Fundus photo; 45-degree field of view
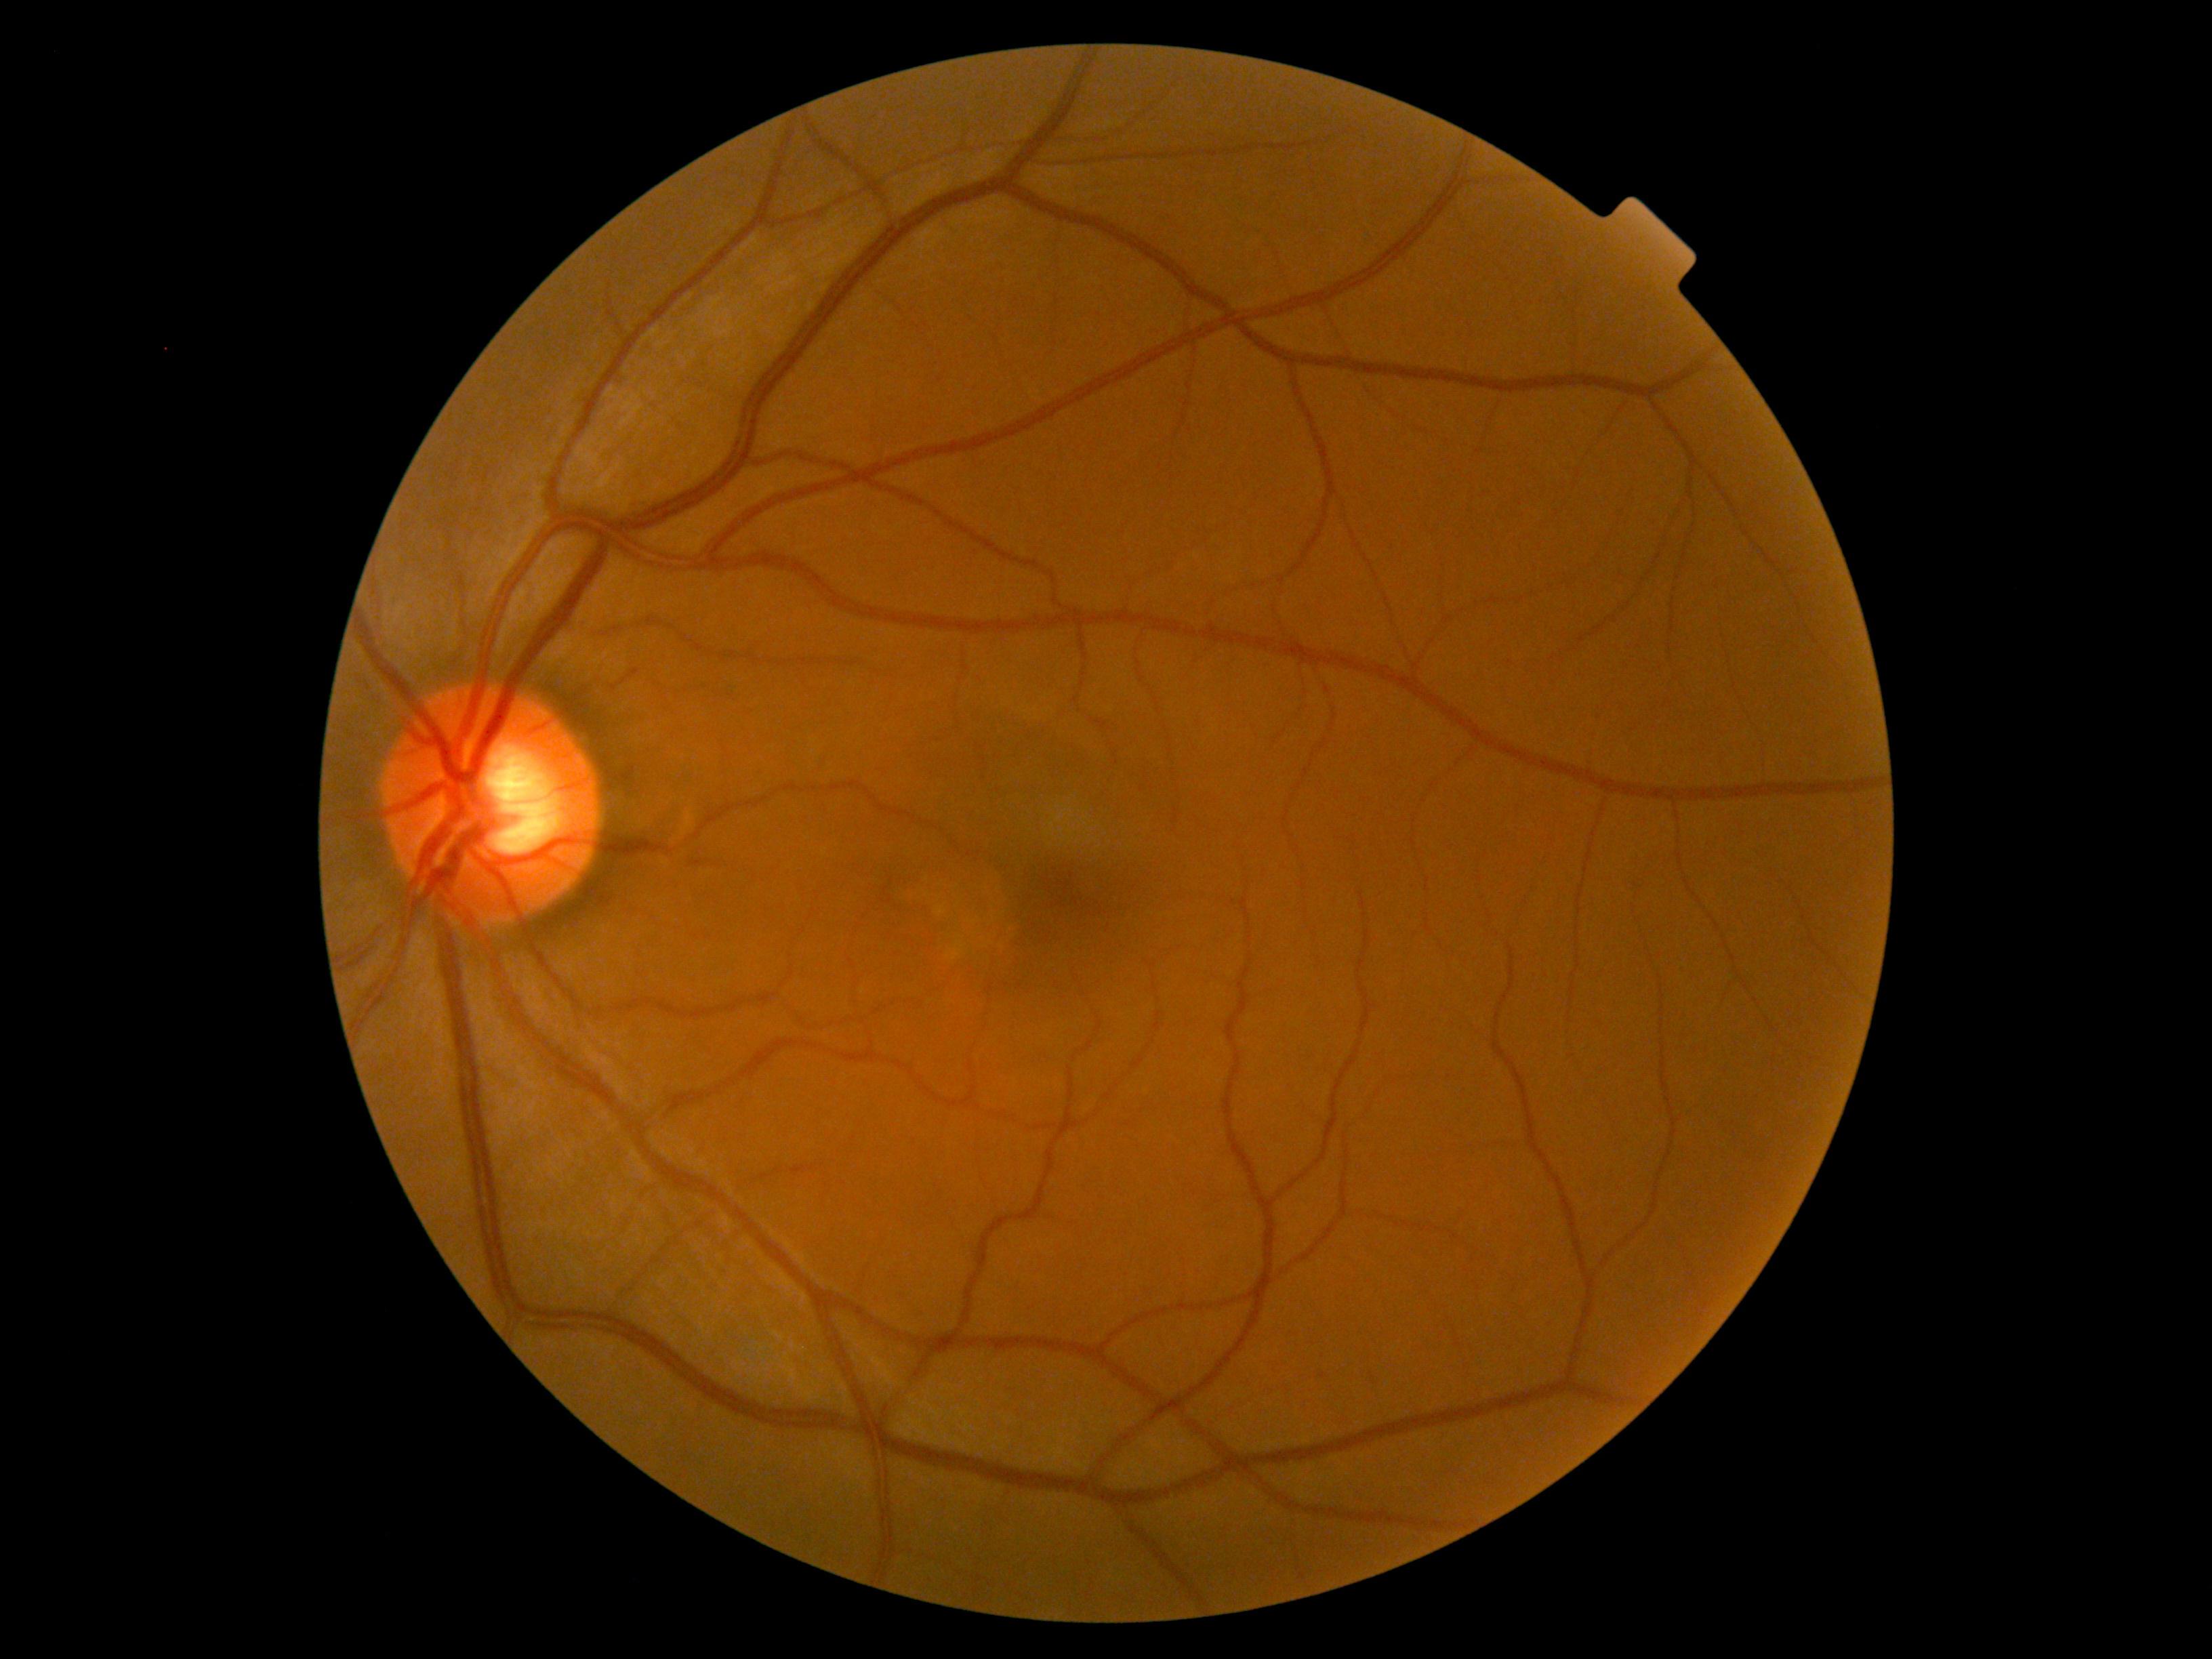 Findings:
- diabetic retinopathy (DR) — grade 0 (no apparent retinopathy)